CFP.
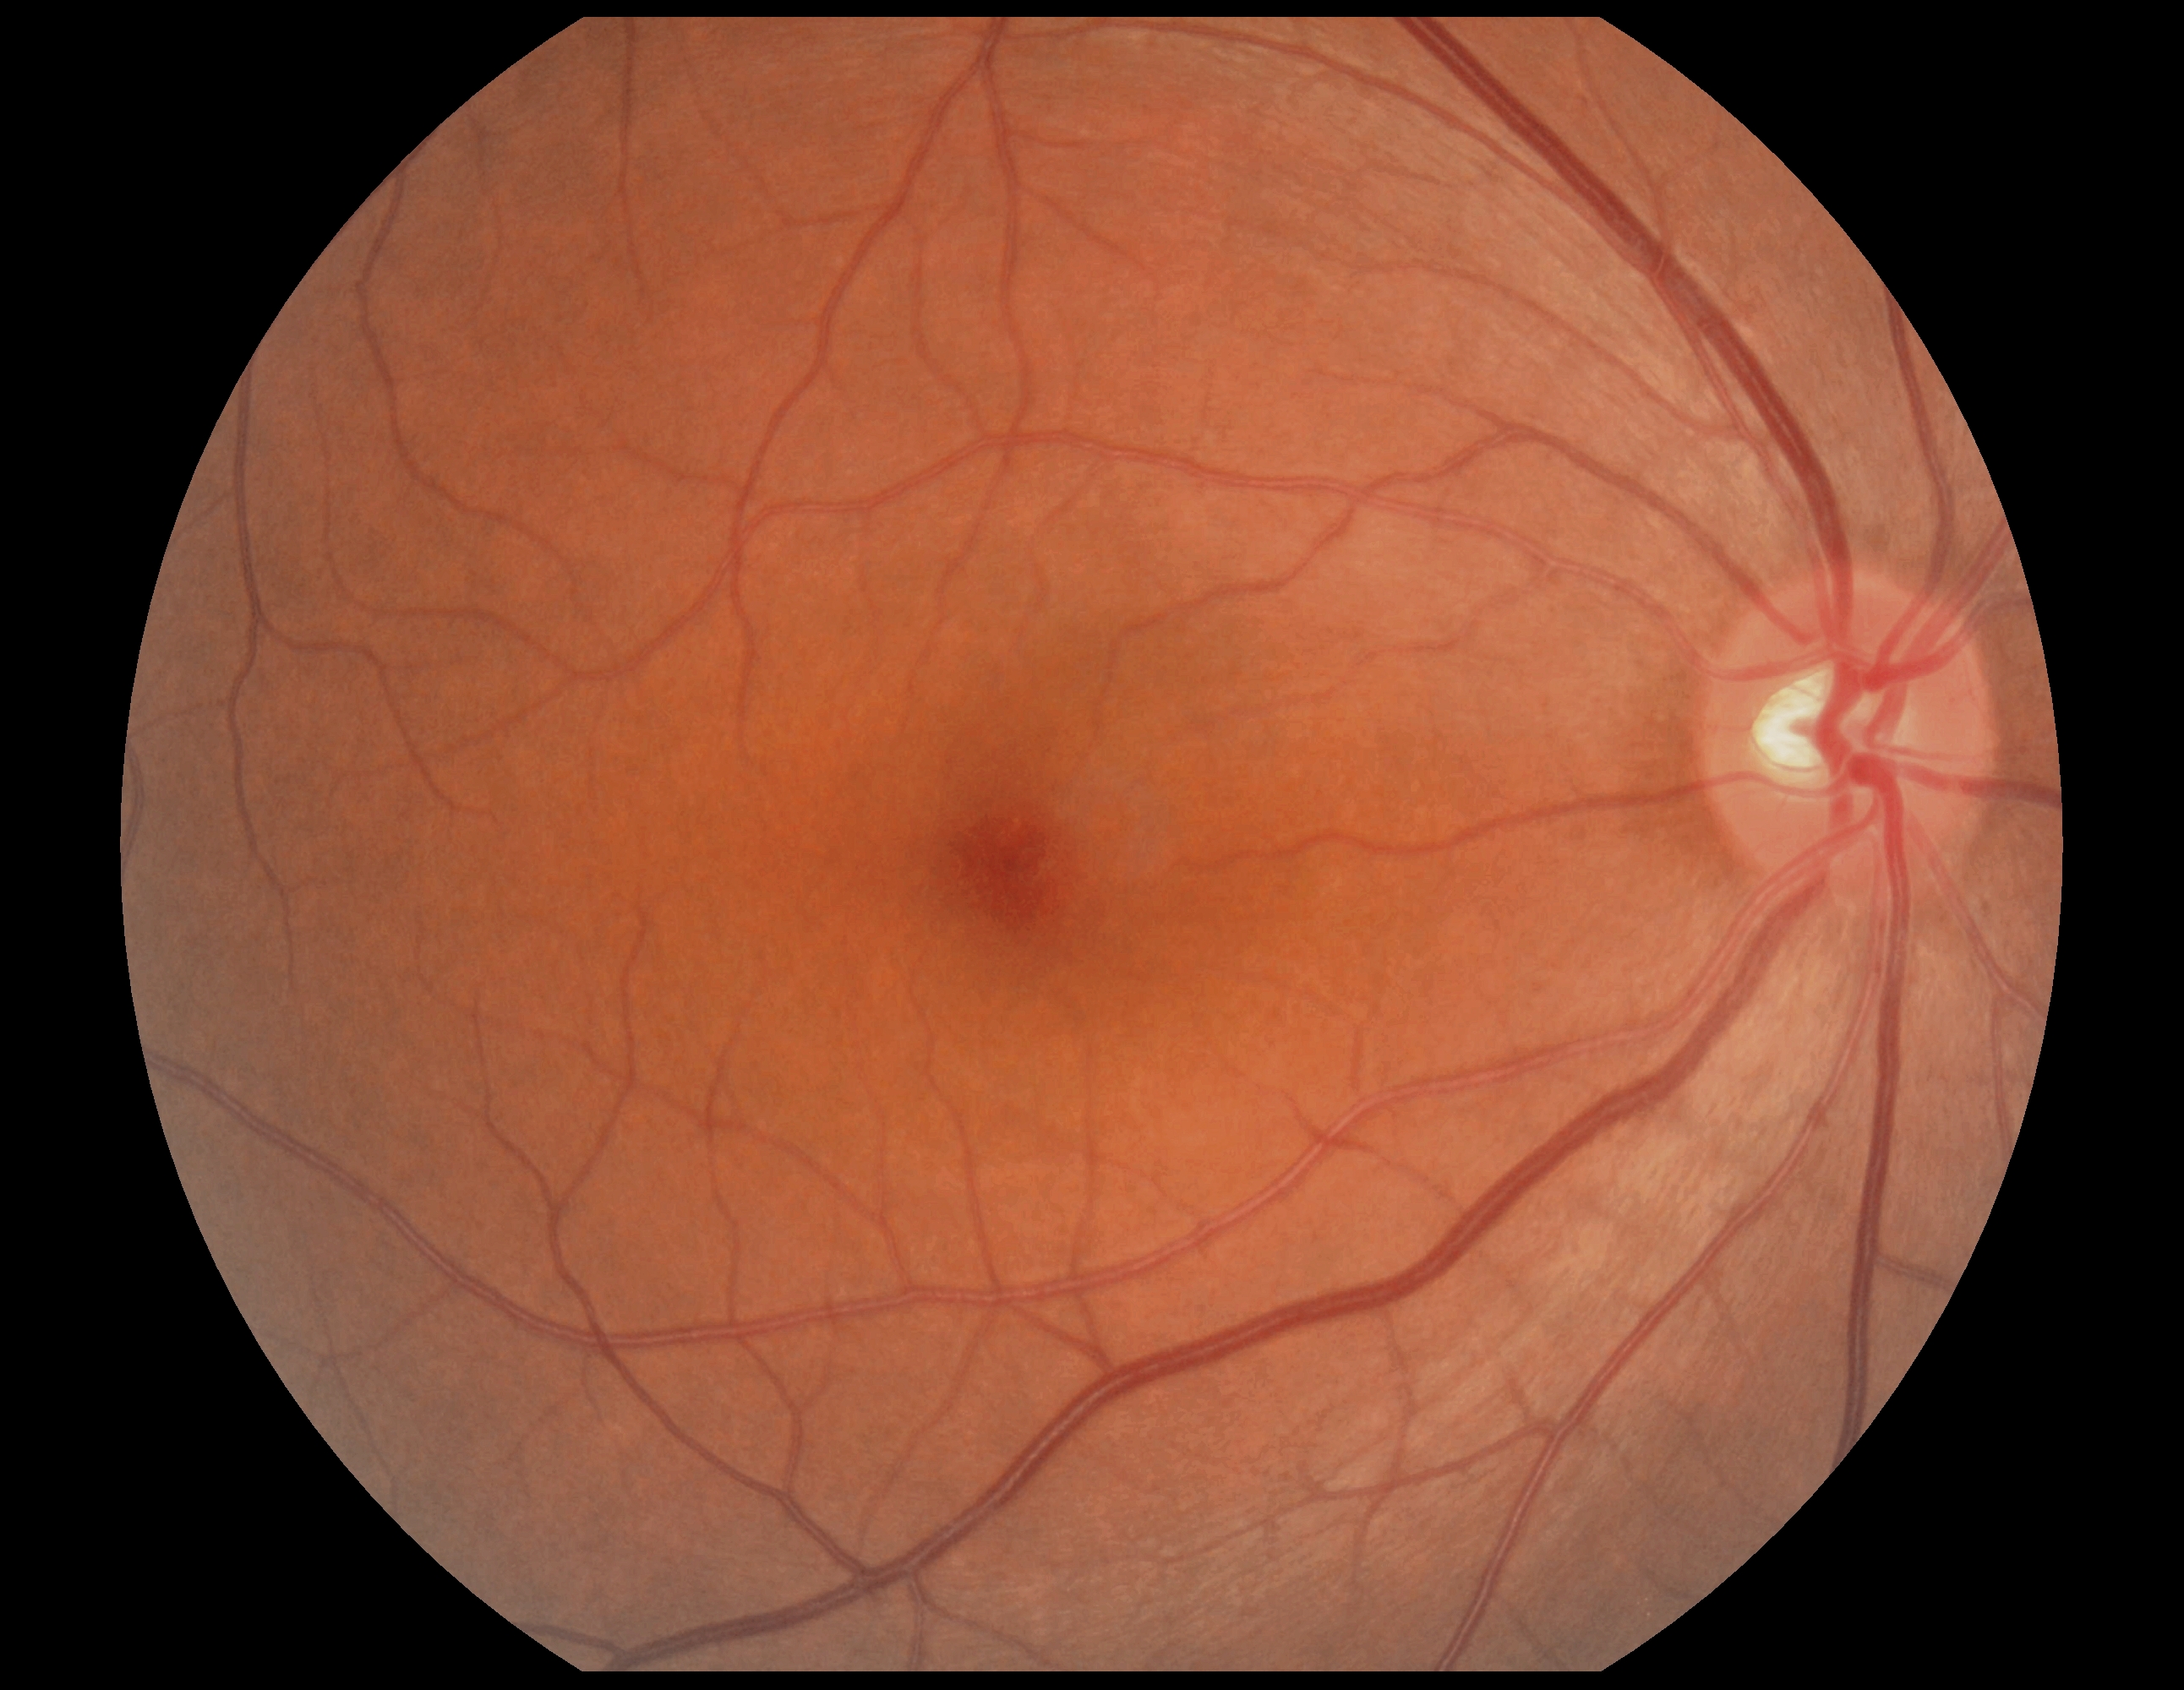

DR impression: negative for DR, DR grade: 0 — no visible signs of diabetic retinopathy.